1504 x 1000 pixels. Color fundus photograph
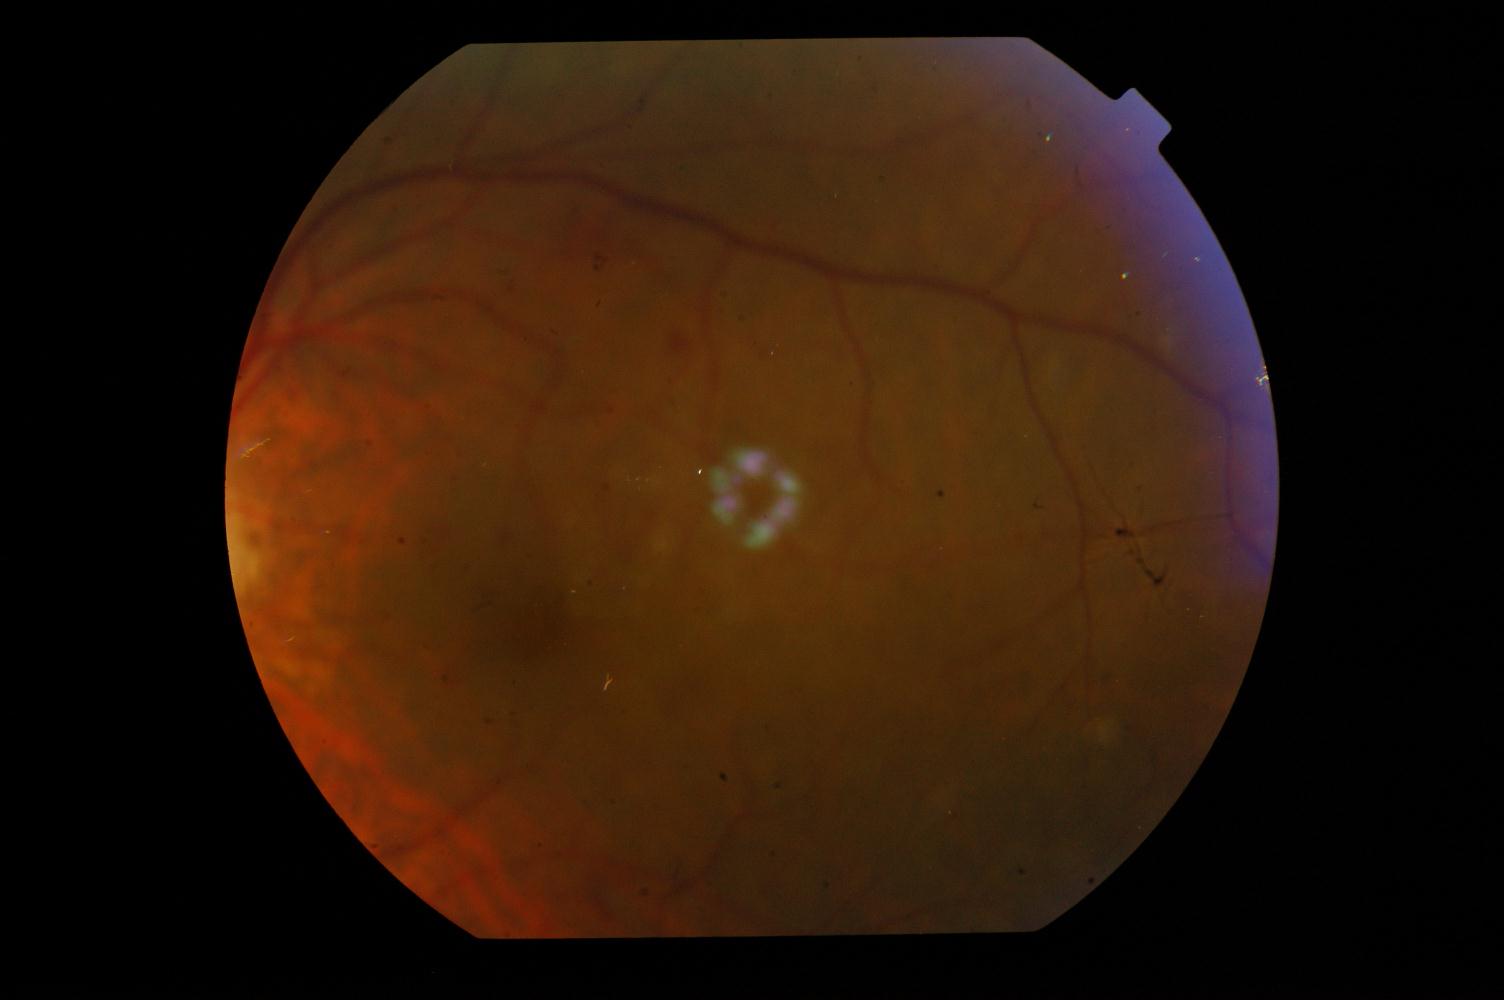 Abnormalities: diabetic retinopathy (DR).